Camera: NIDEK AFC-230, 45 degree fundus photograph, DR severity per modified Davis staging, image size 848x848, nonmydriatic, fundus photo — 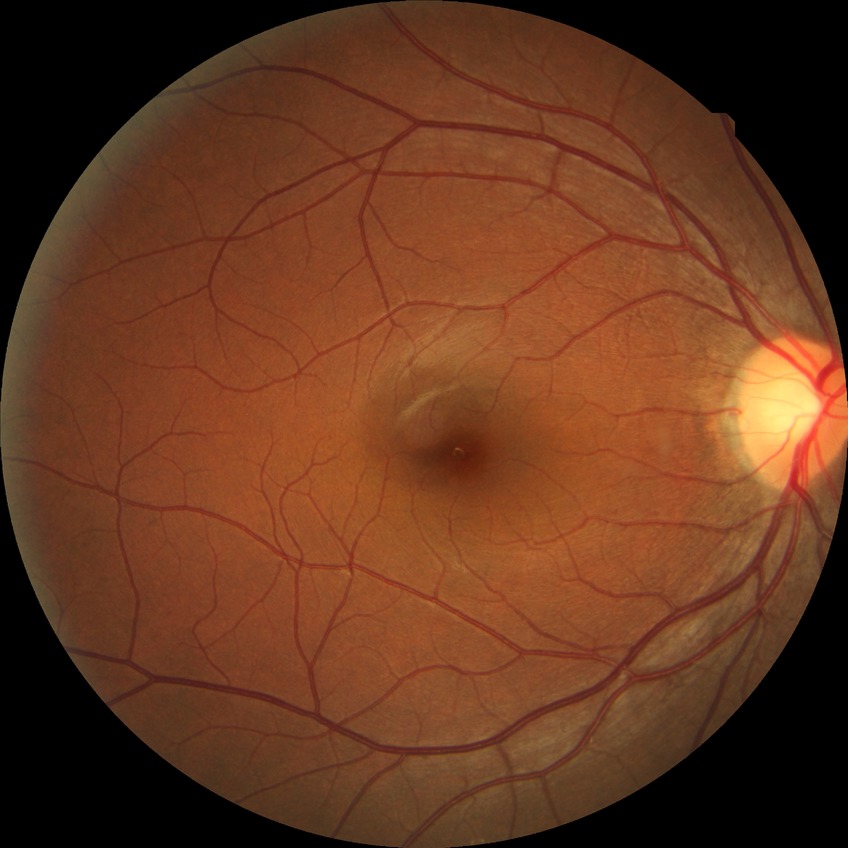 modified Davis grading=no diabetic retinopathy.